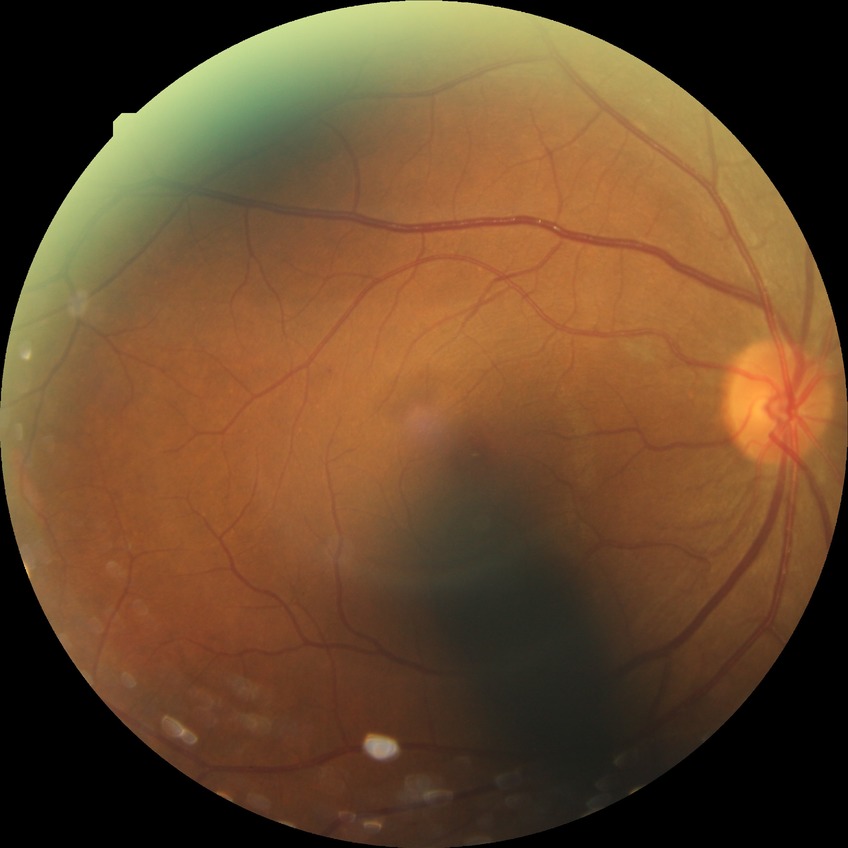
The retinopathy is classified as non-proliferative diabetic retinopathy.
Diabetic retinopathy stage is simple diabetic retinopathy.